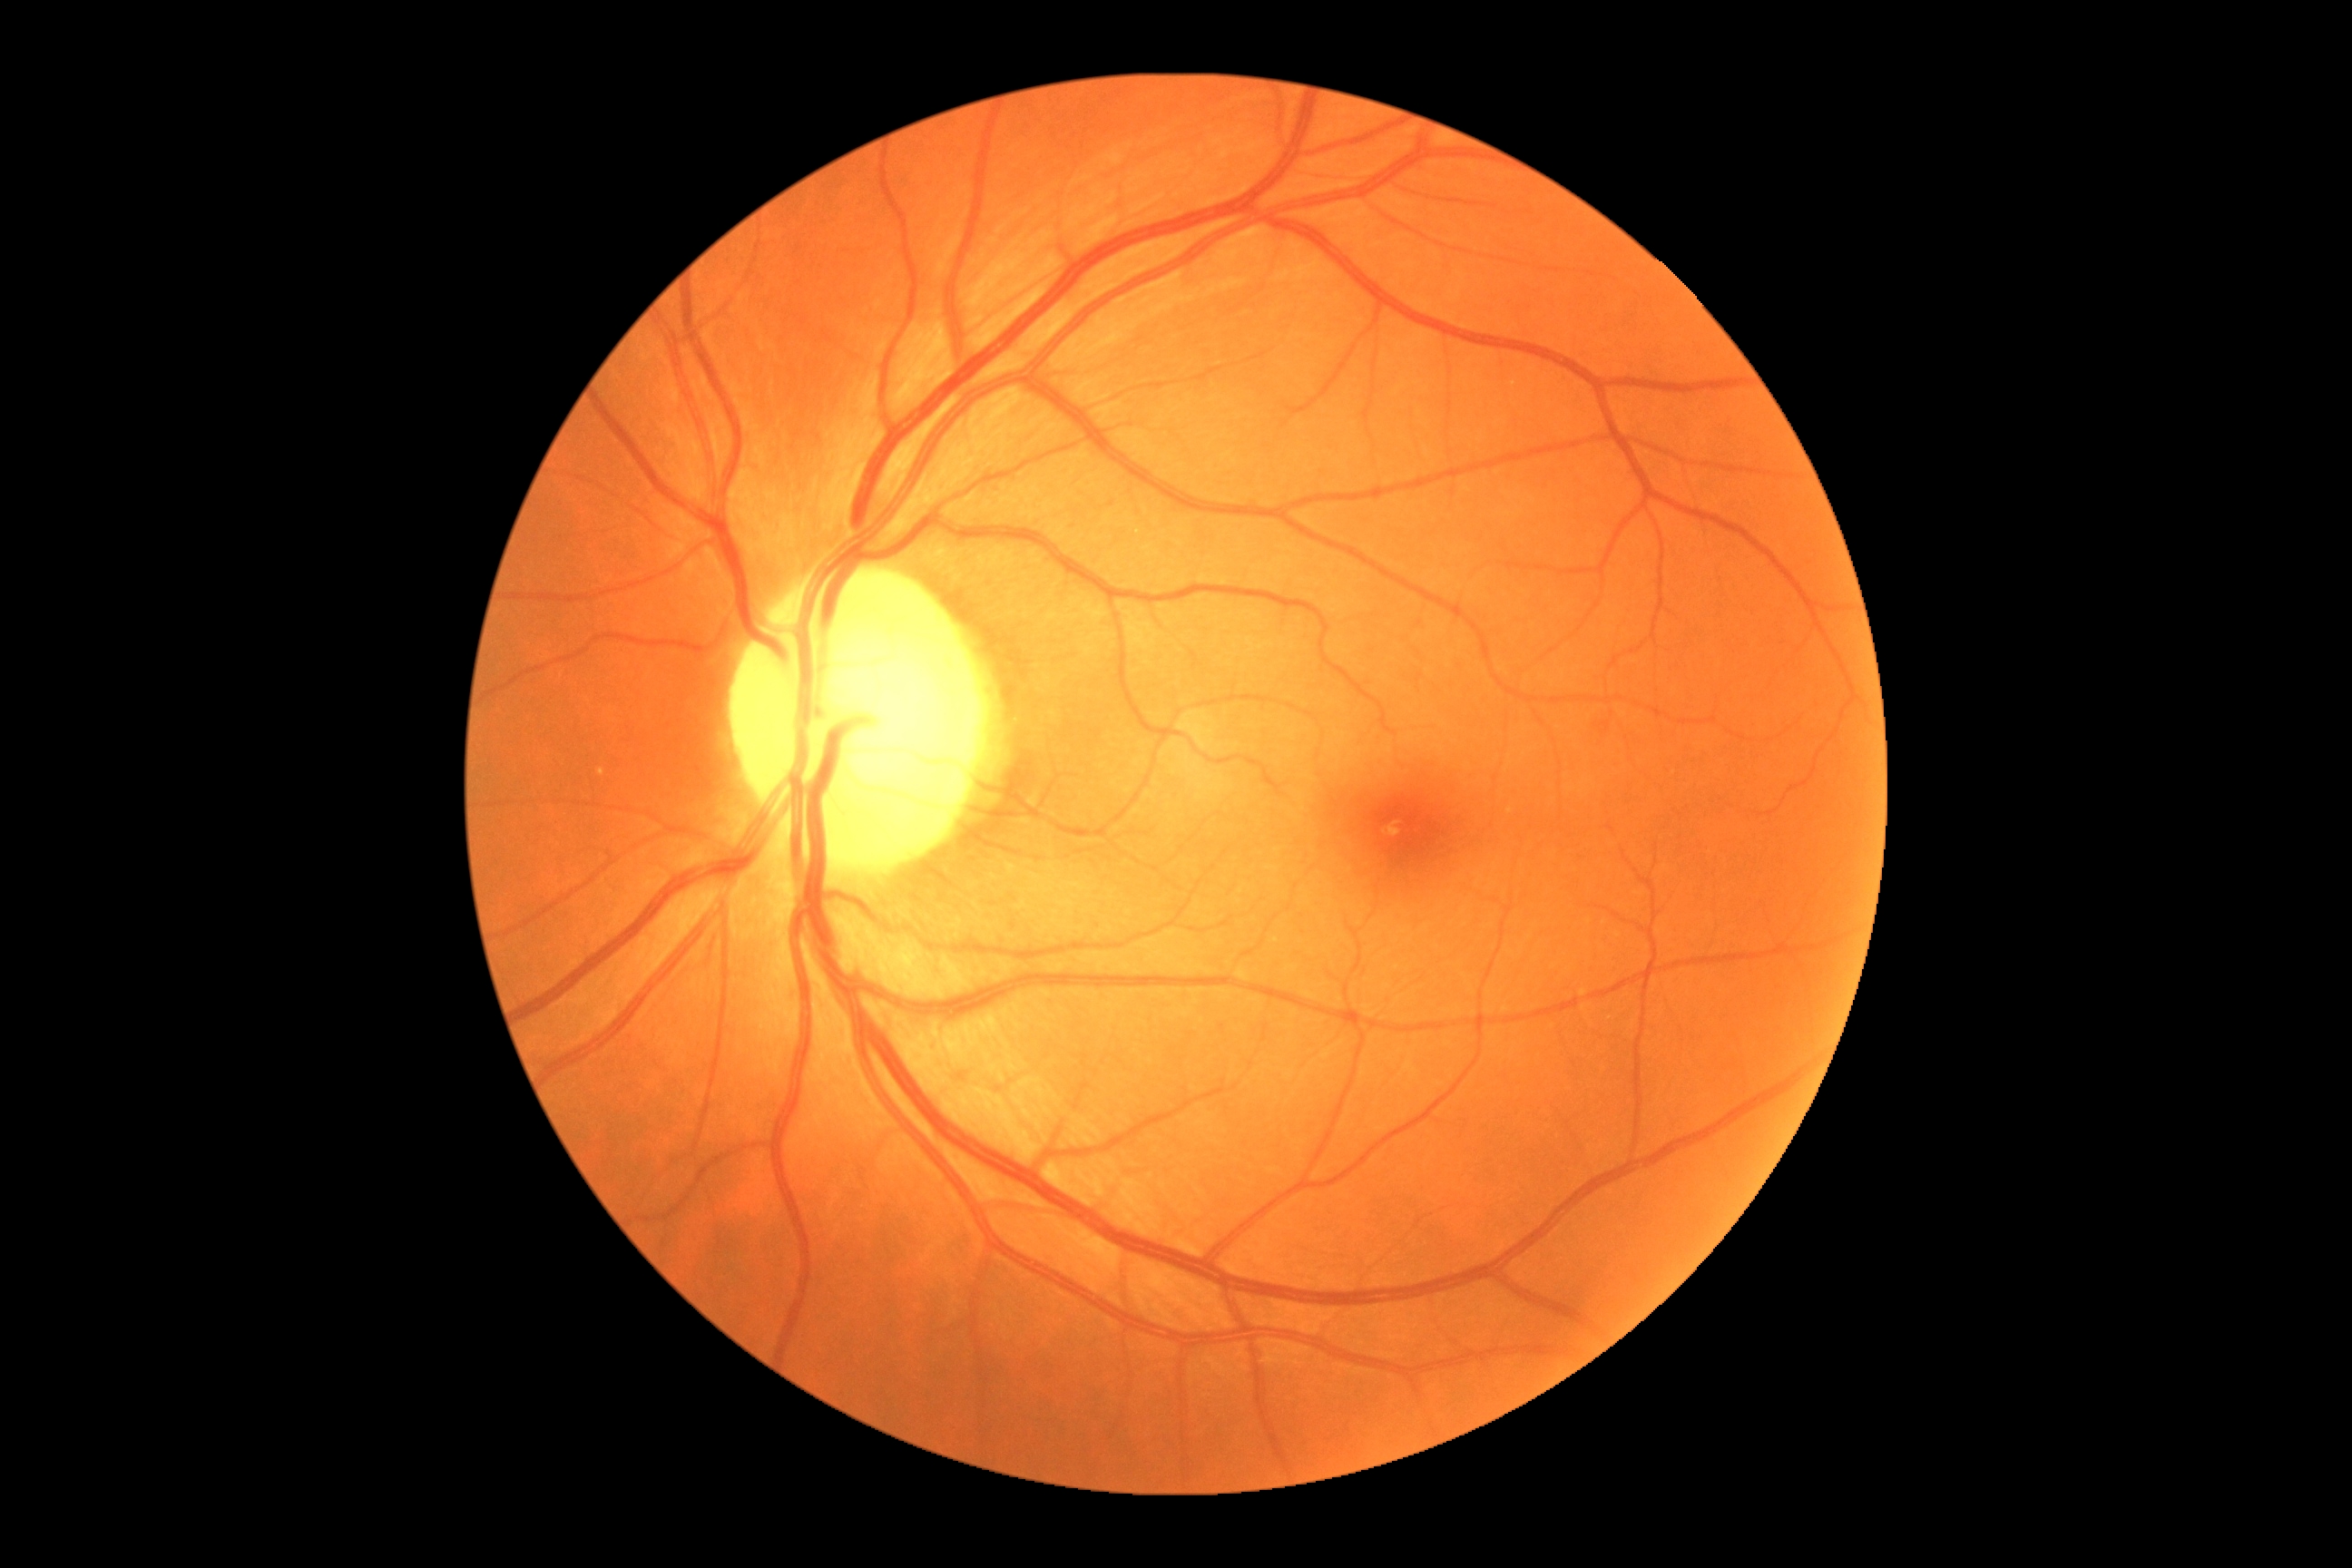

dr_grade: no apparent diabetic retinopathy (grade 0)